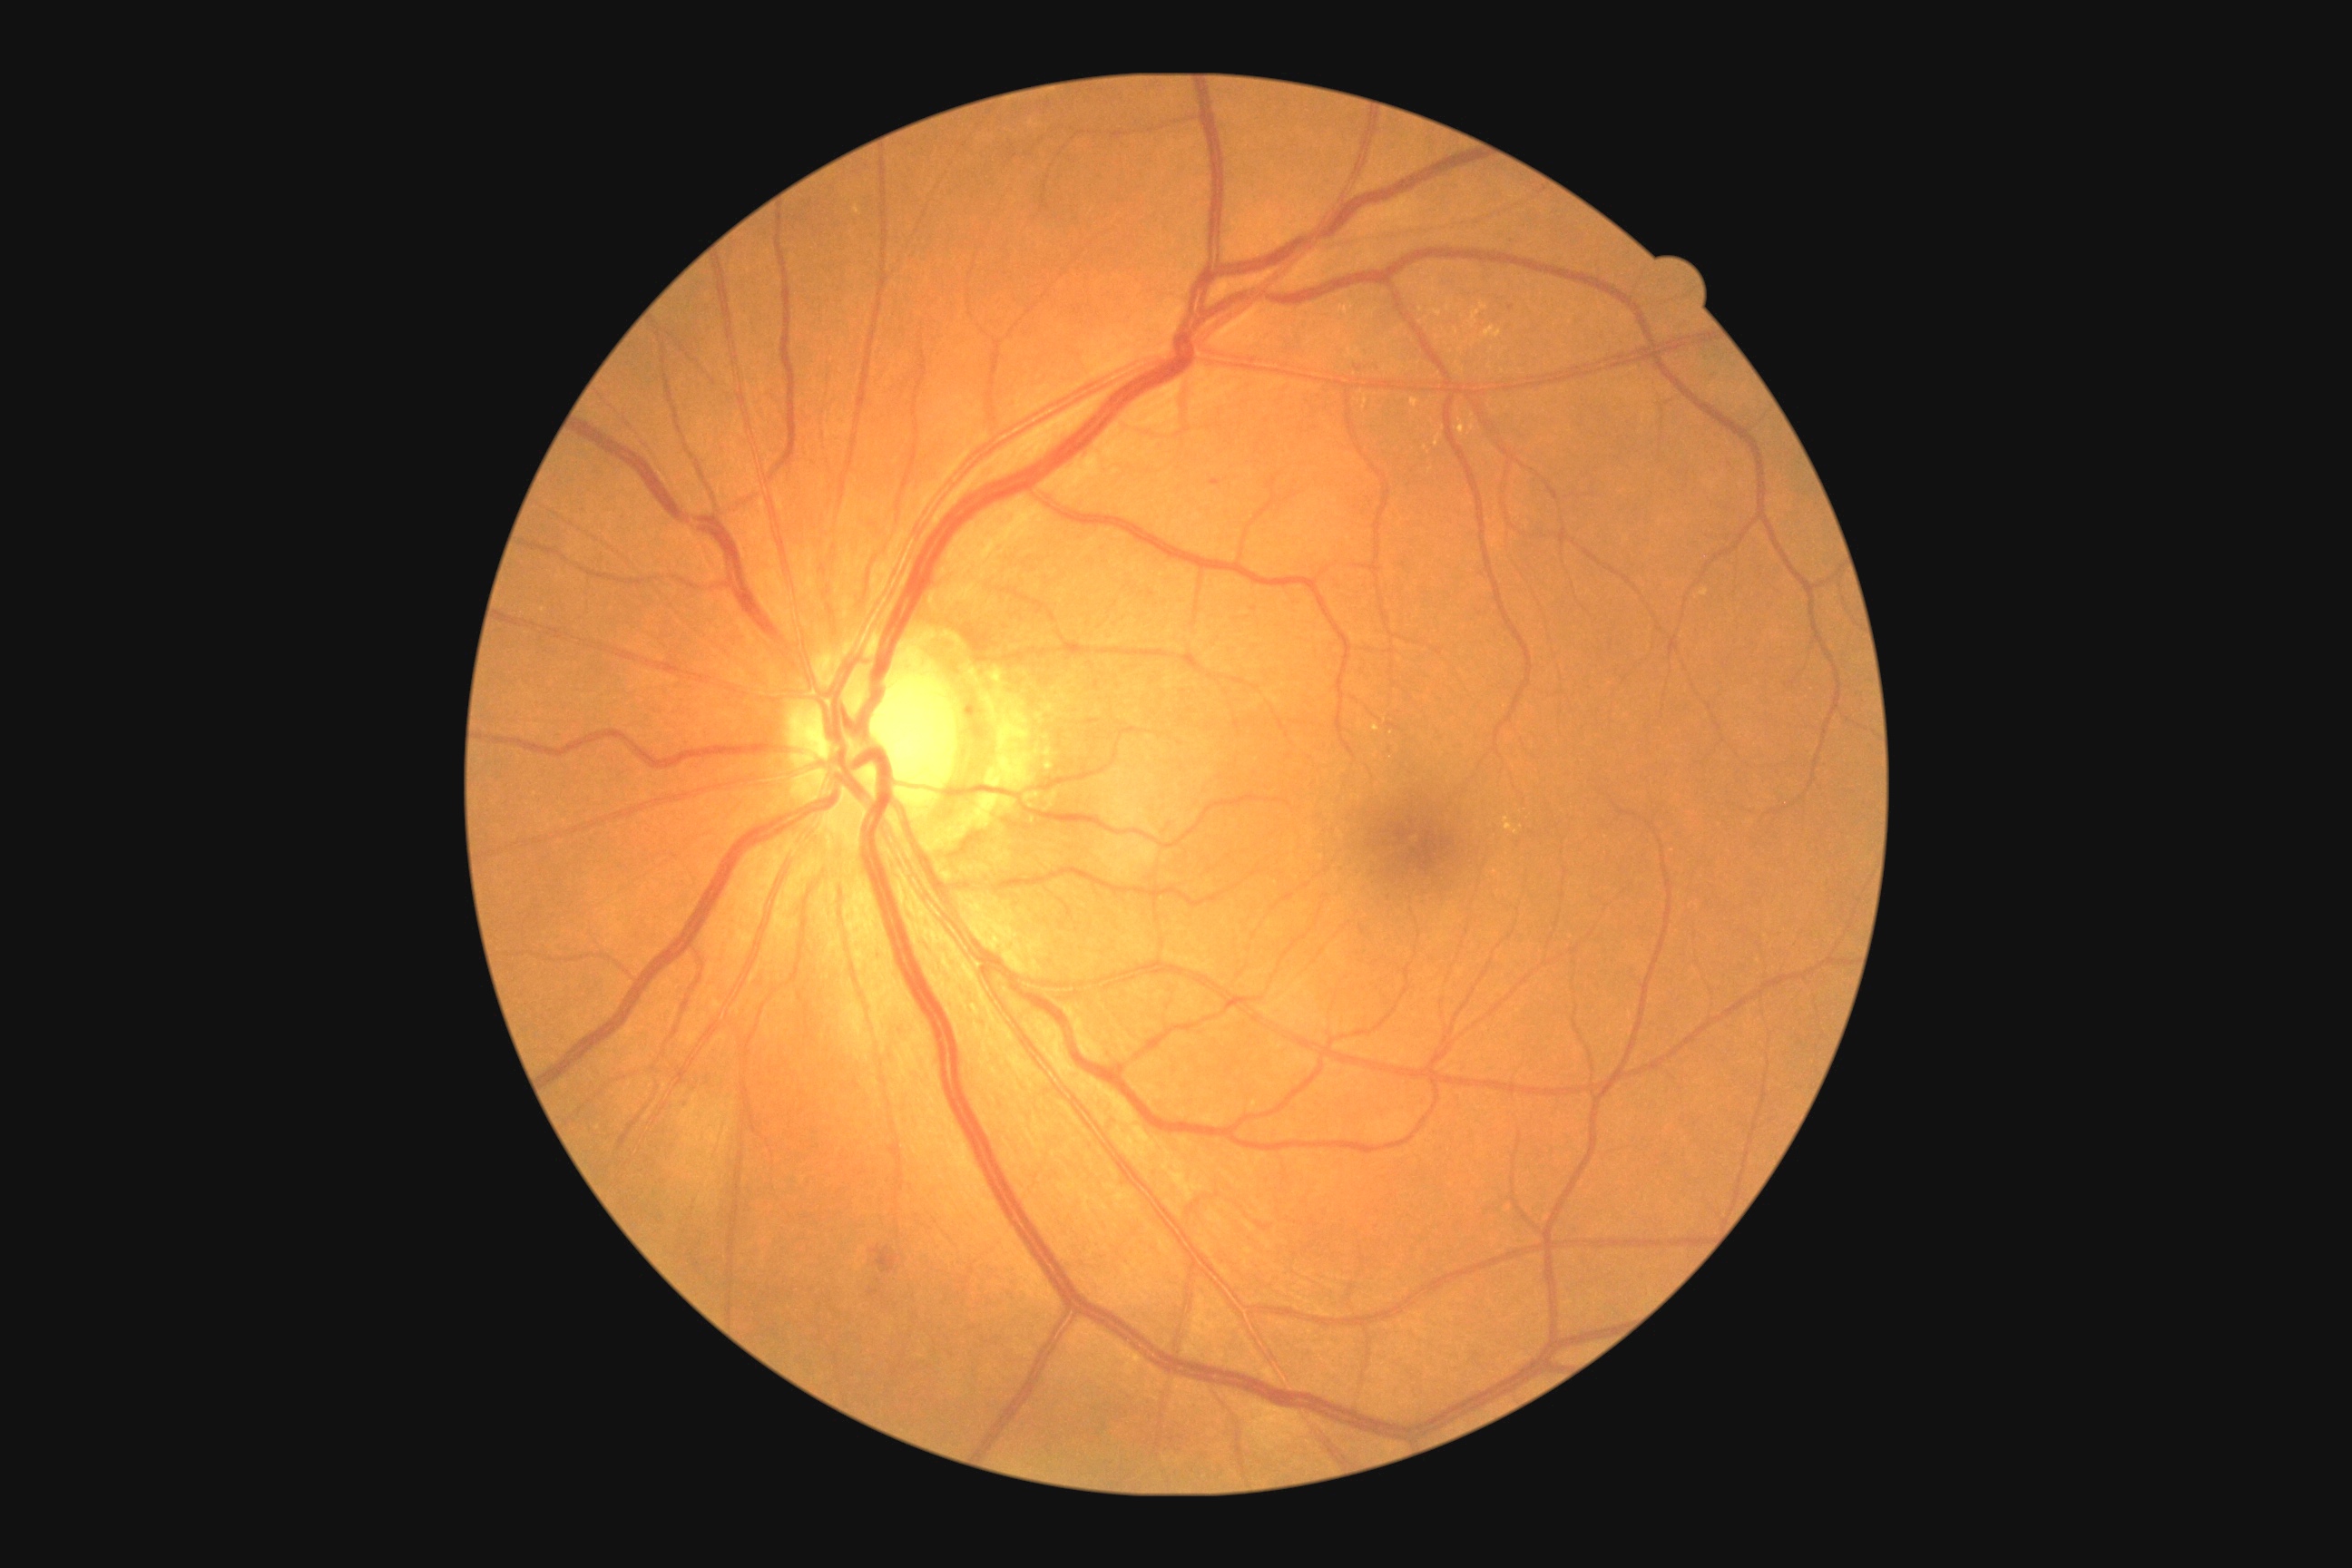
The retinopathy is classified as non-proliferative diabetic retinopathy. DR severity is 2/4.